Pediatric wide-field fundus photograph — 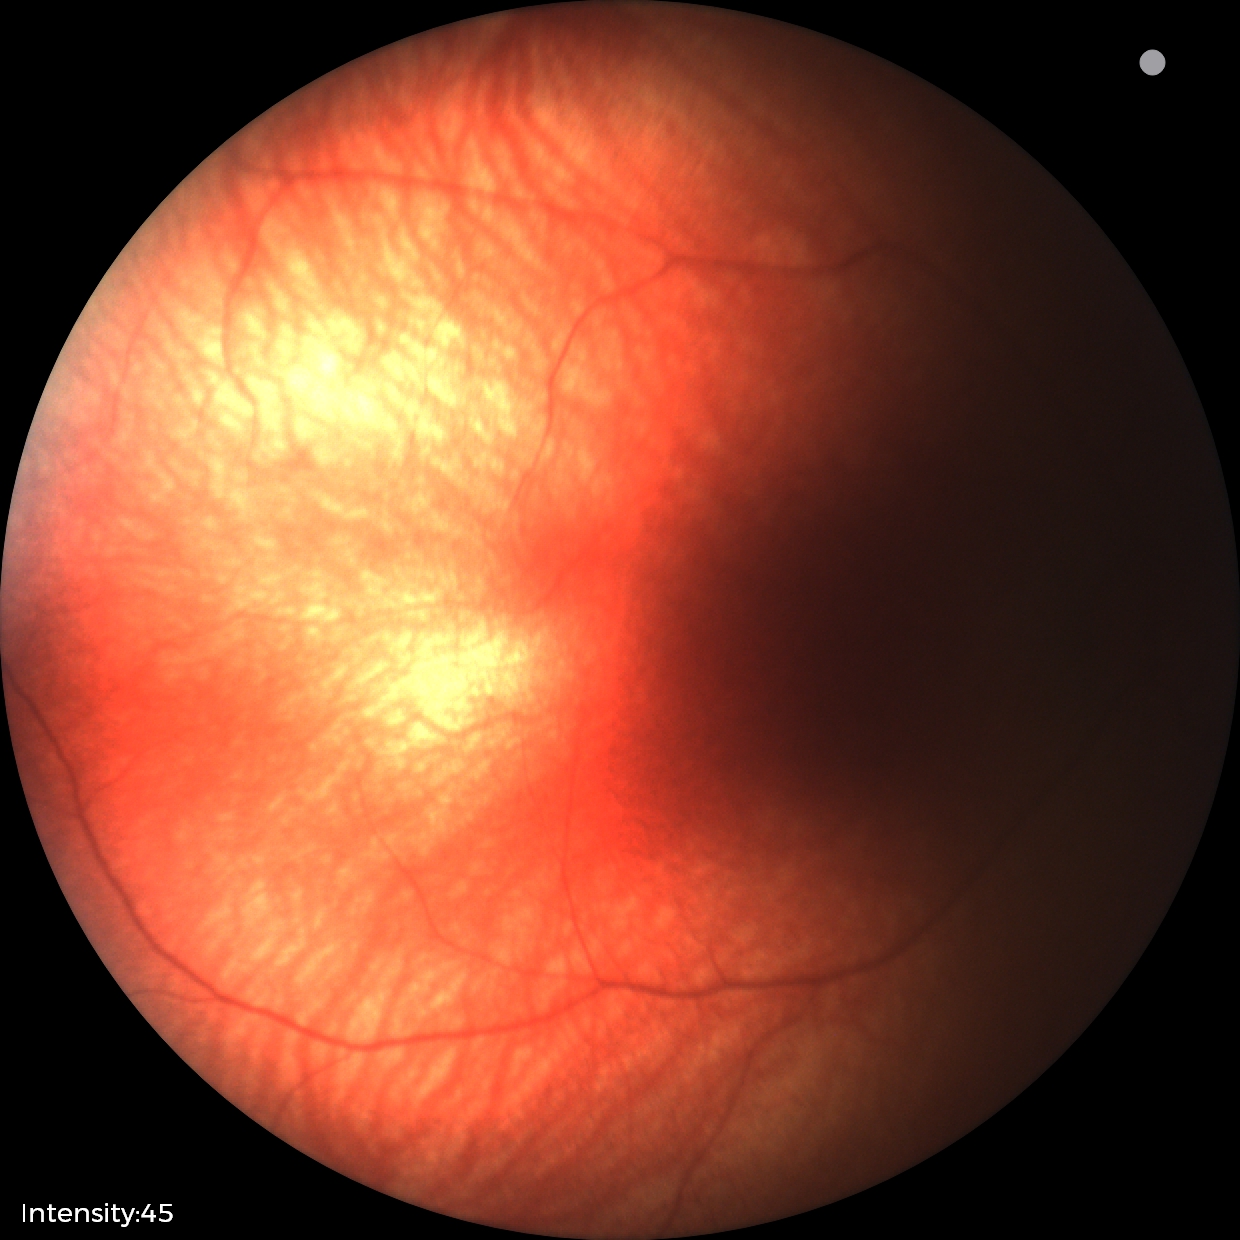
Screening examination diagnosed as physiological.